Acquired with a NIDEK AFC-230 · 45 degree fundus photograph.
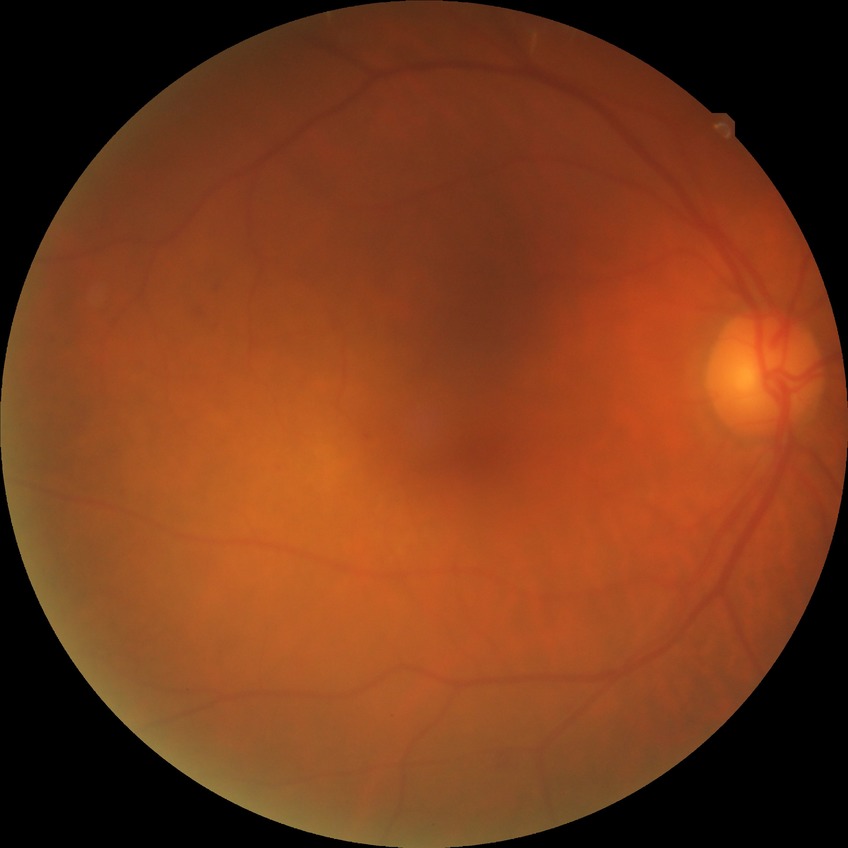 DR stage: SDR.